NIDEK AFC-230, modified Davis grading, retinal fundus photograph, 848 x 848 pixels, nonmydriatic:
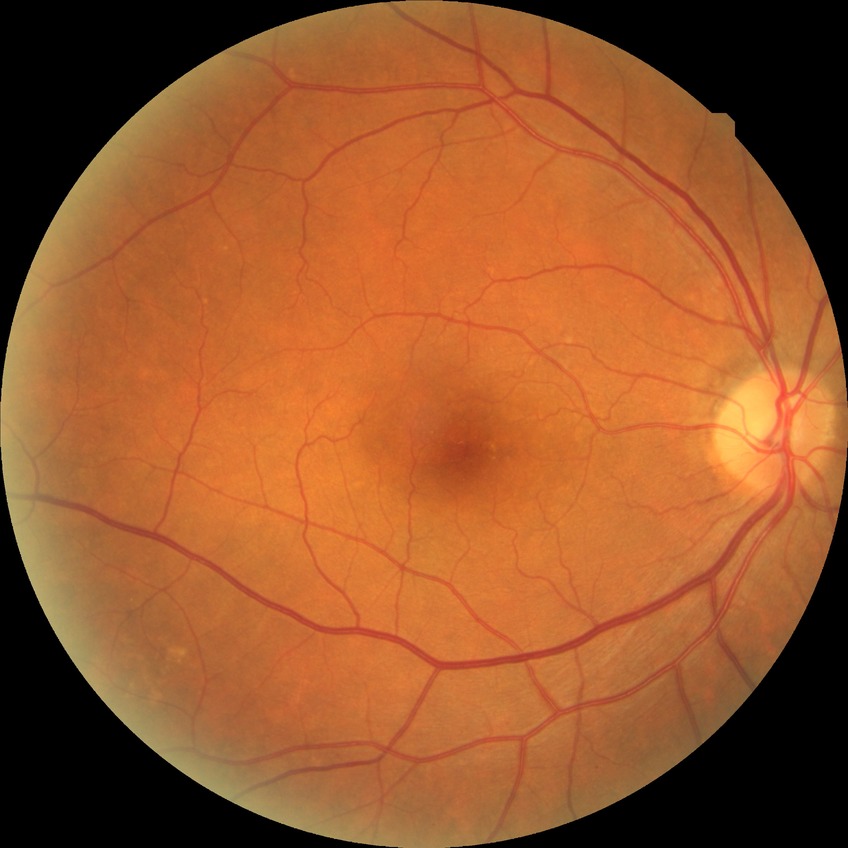

Findings:
– diabetic retinopathy (DR): no diabetic retinopathy (NDR)